45-degree field of view.
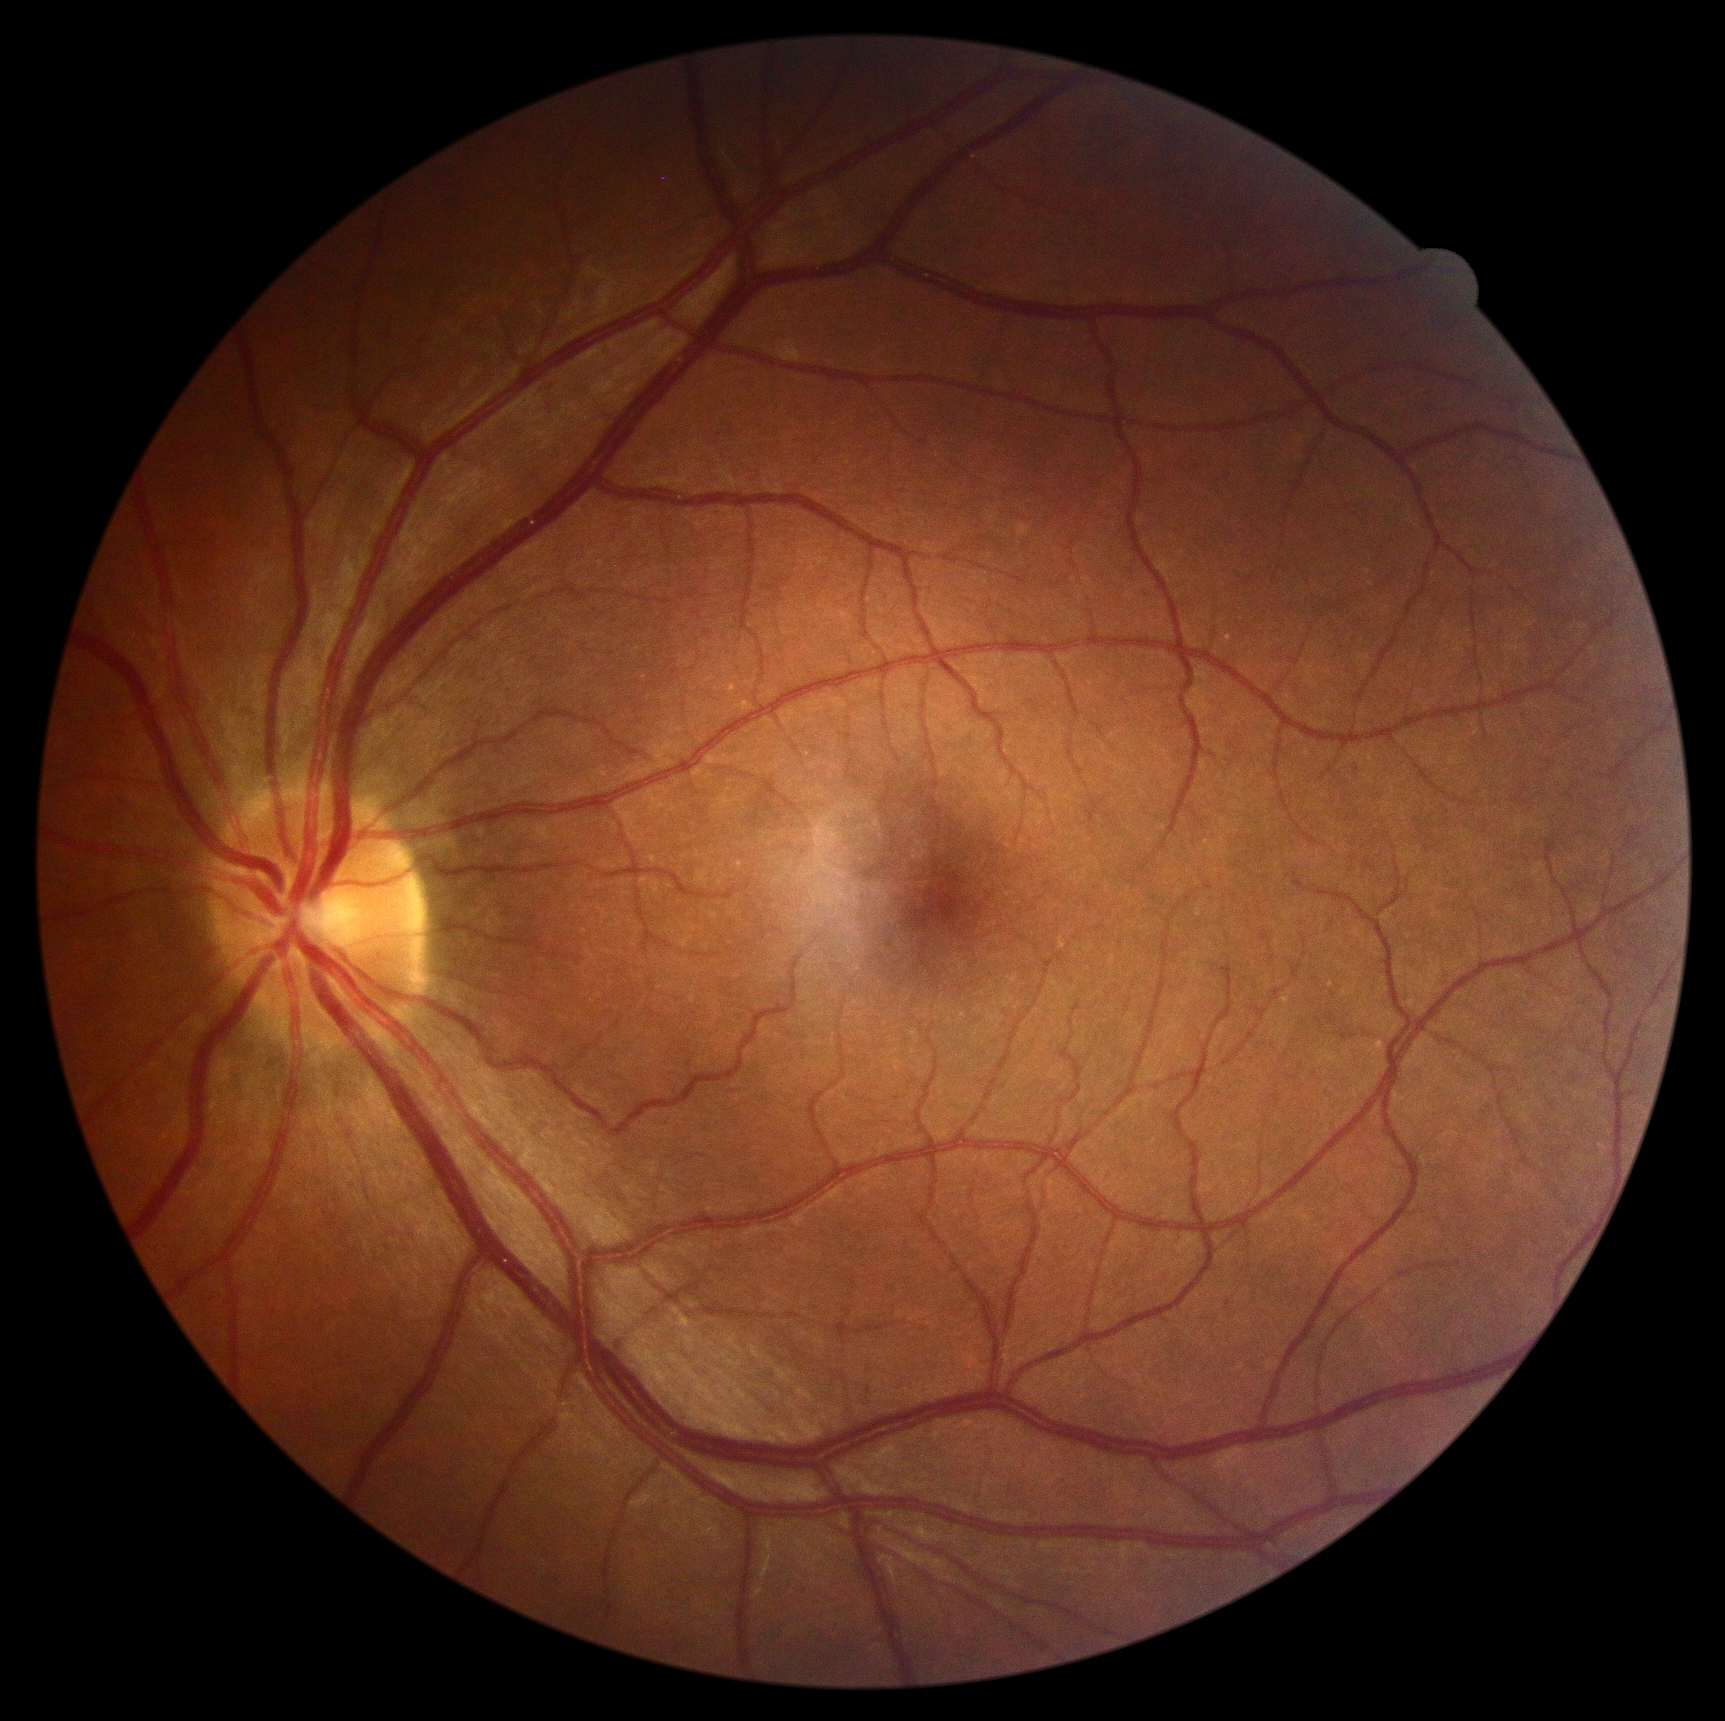 * DR severity — grade 0 (no apparent retinopathy)